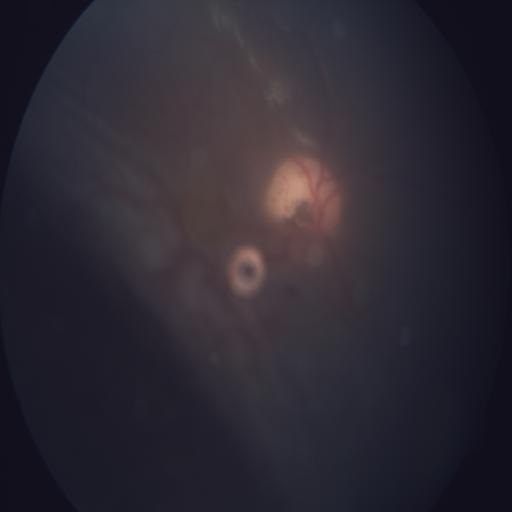
Retinal fundus photograph demonstrating retinal detachment.